RetCam wide-field infant fundus image. Acquired on the Natus RetCam Envision. 1440x1080:
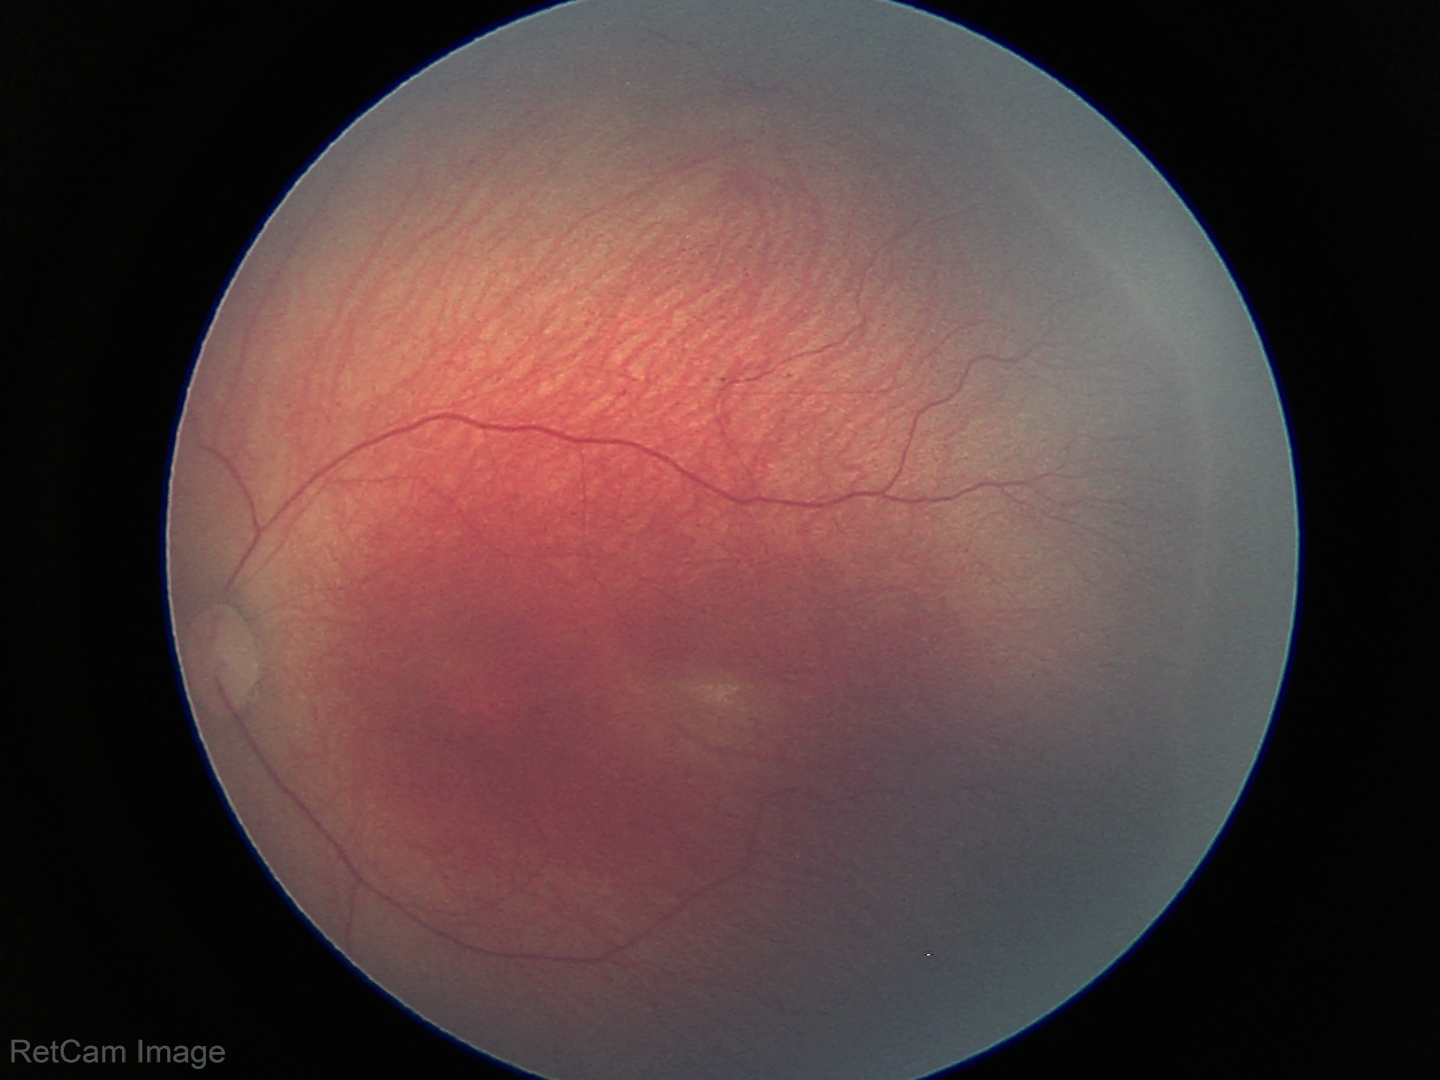
Without plus disease. From an examination with diagnosis of ROP stage 2.